50-degree field of view, field includes the optic disc and macula, pupil-dilated, CFP: 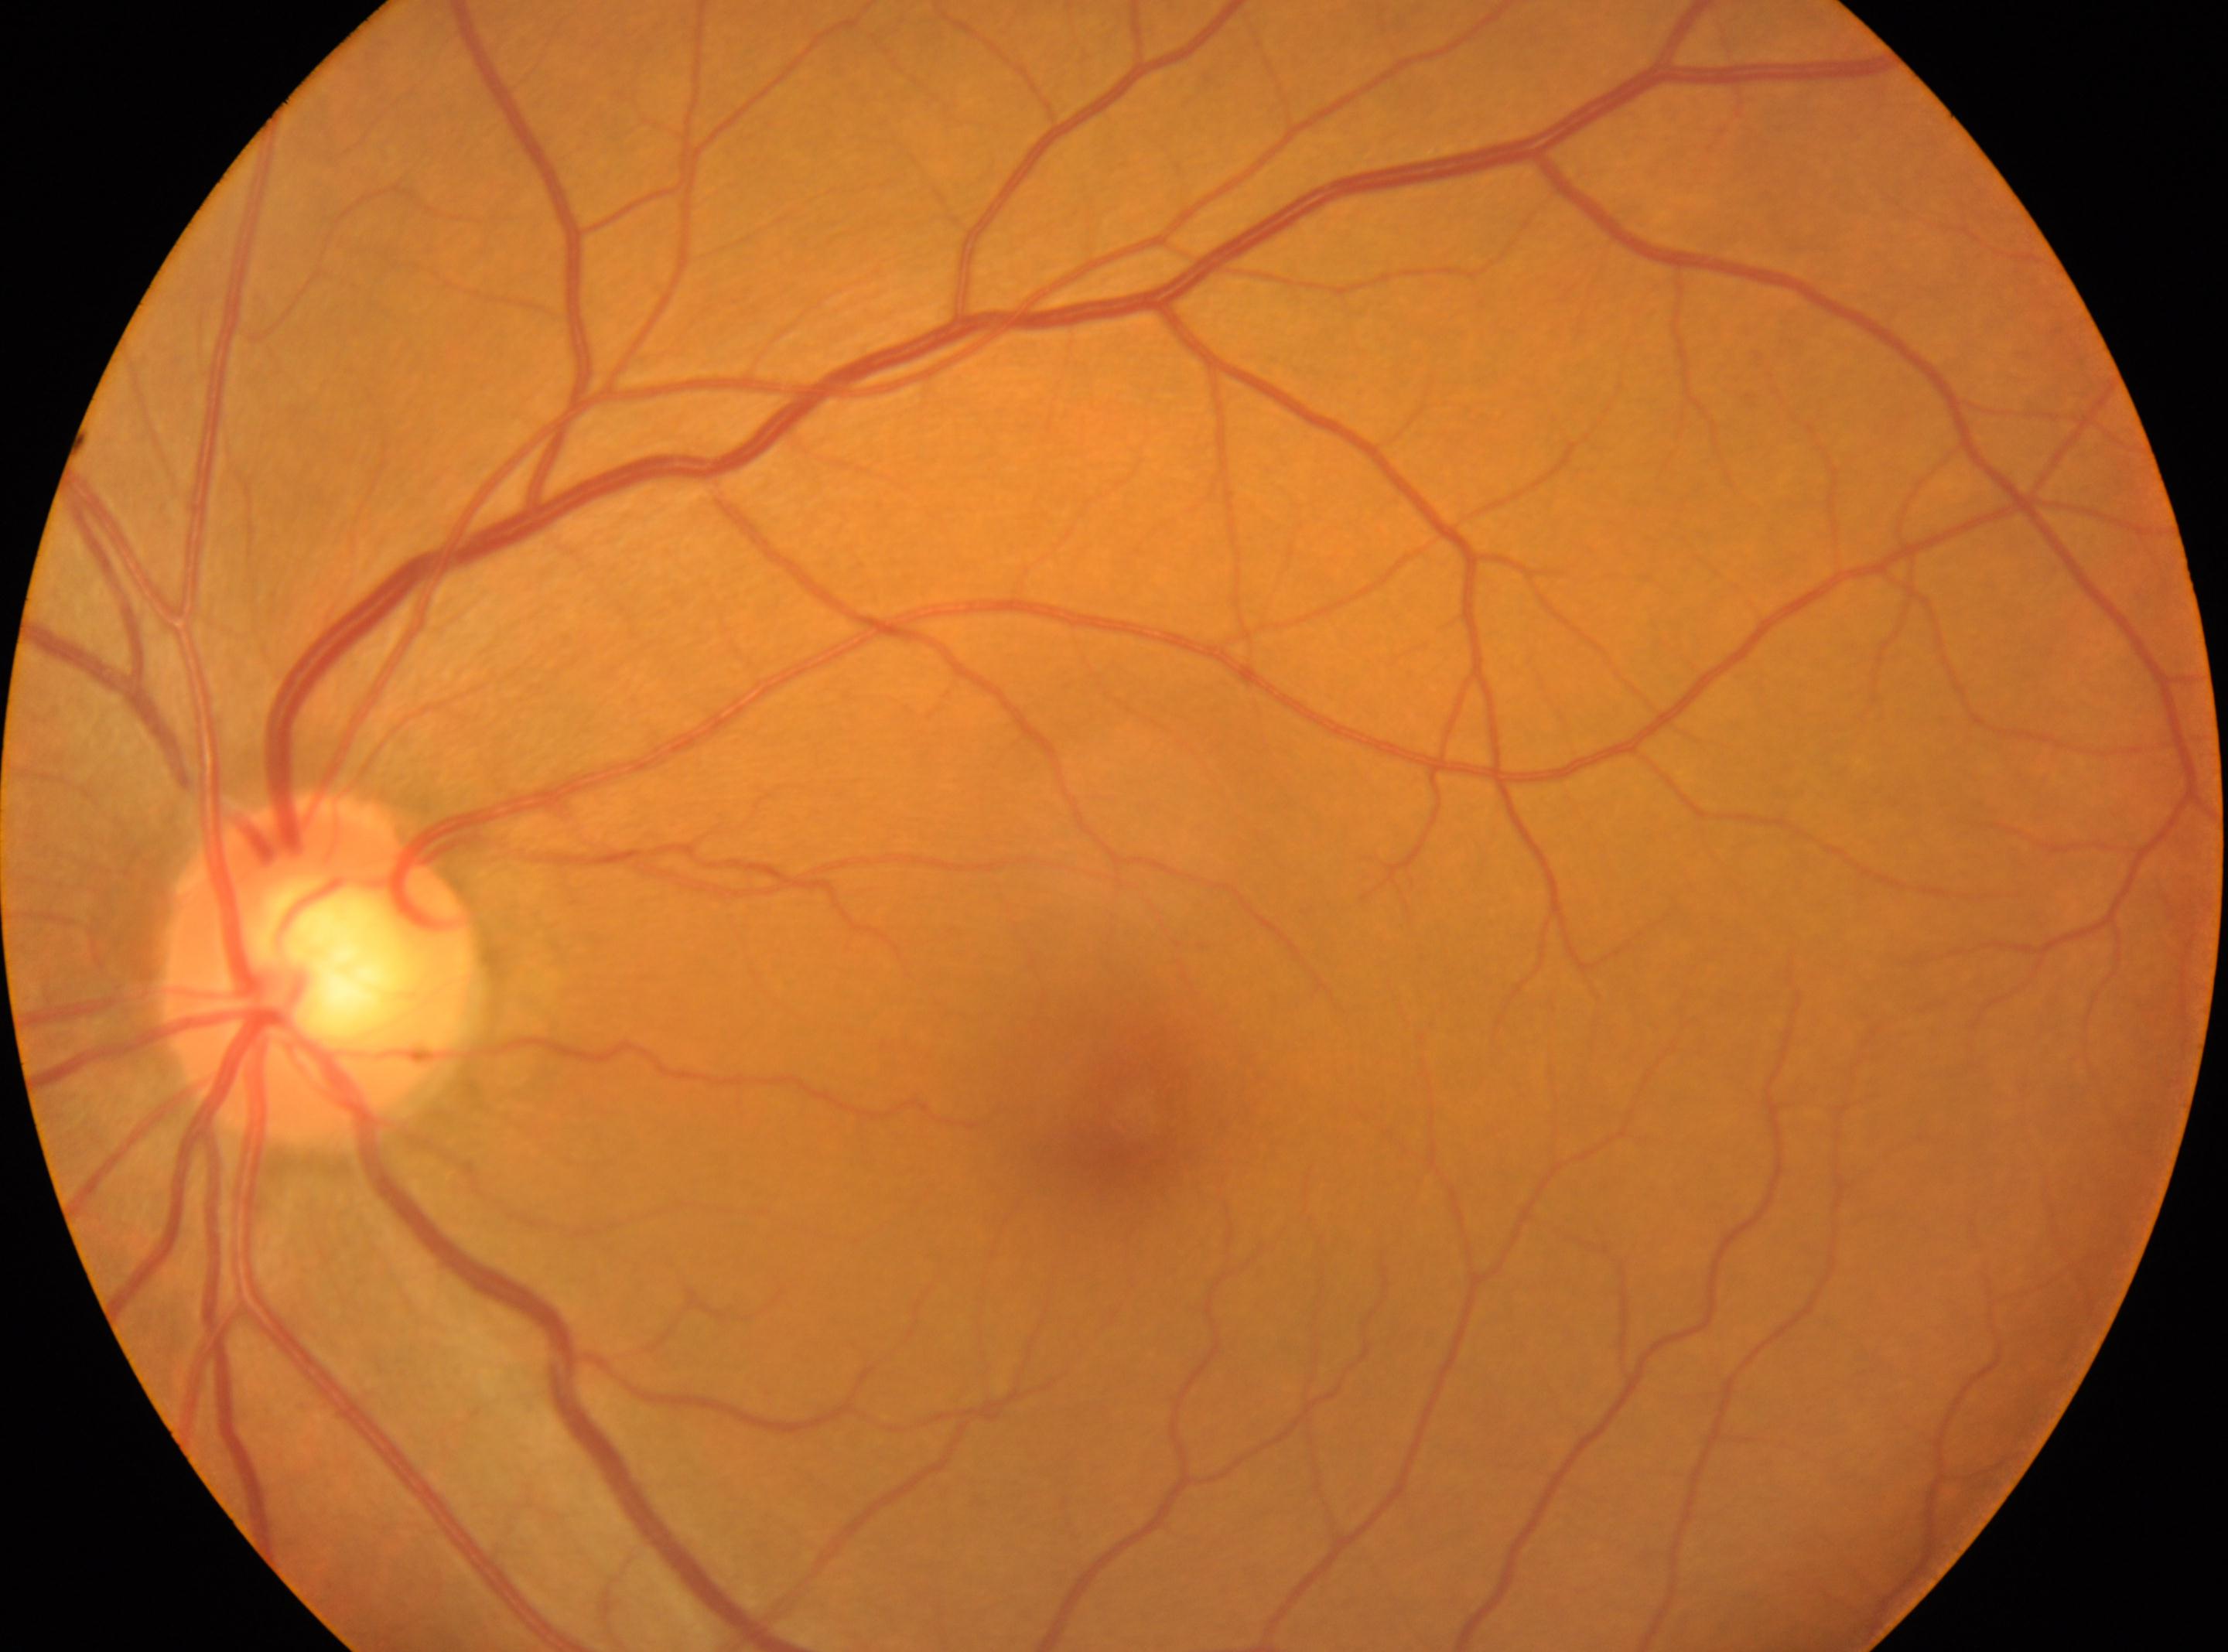 DR severity is 0.
The image shows the oculus sinister.
ONH: (x: 320, y: 968).
The fovea is at (x: 1134, y: 1120).